45 degree fundus photograph — 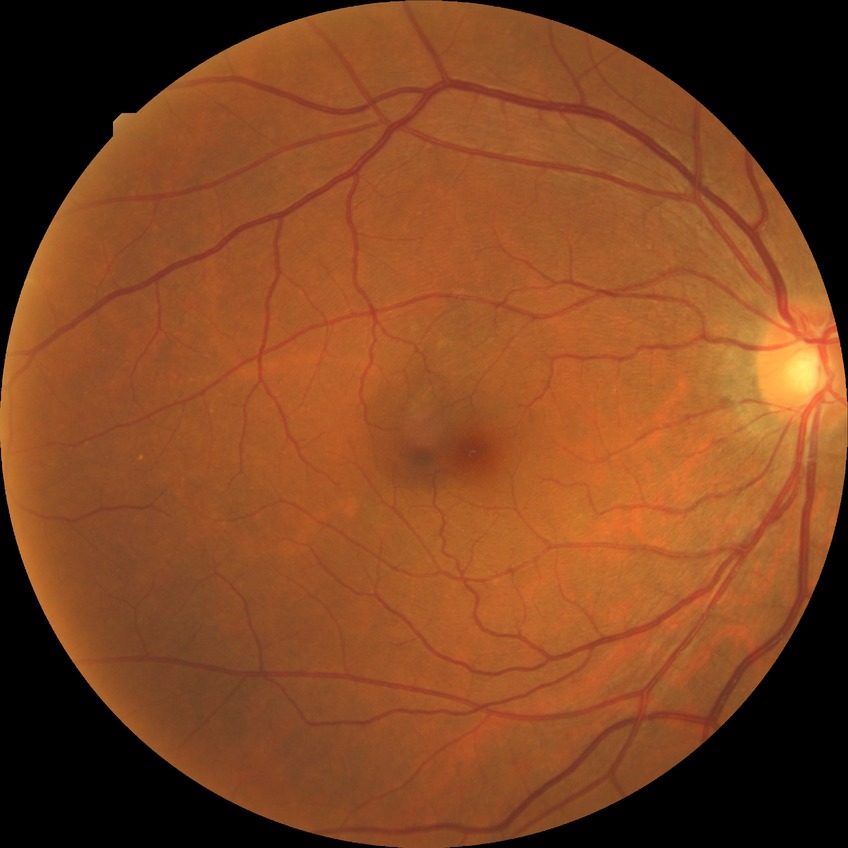
Diabetic retinopathy (DR) is NDR (no diabetic retinopathy).